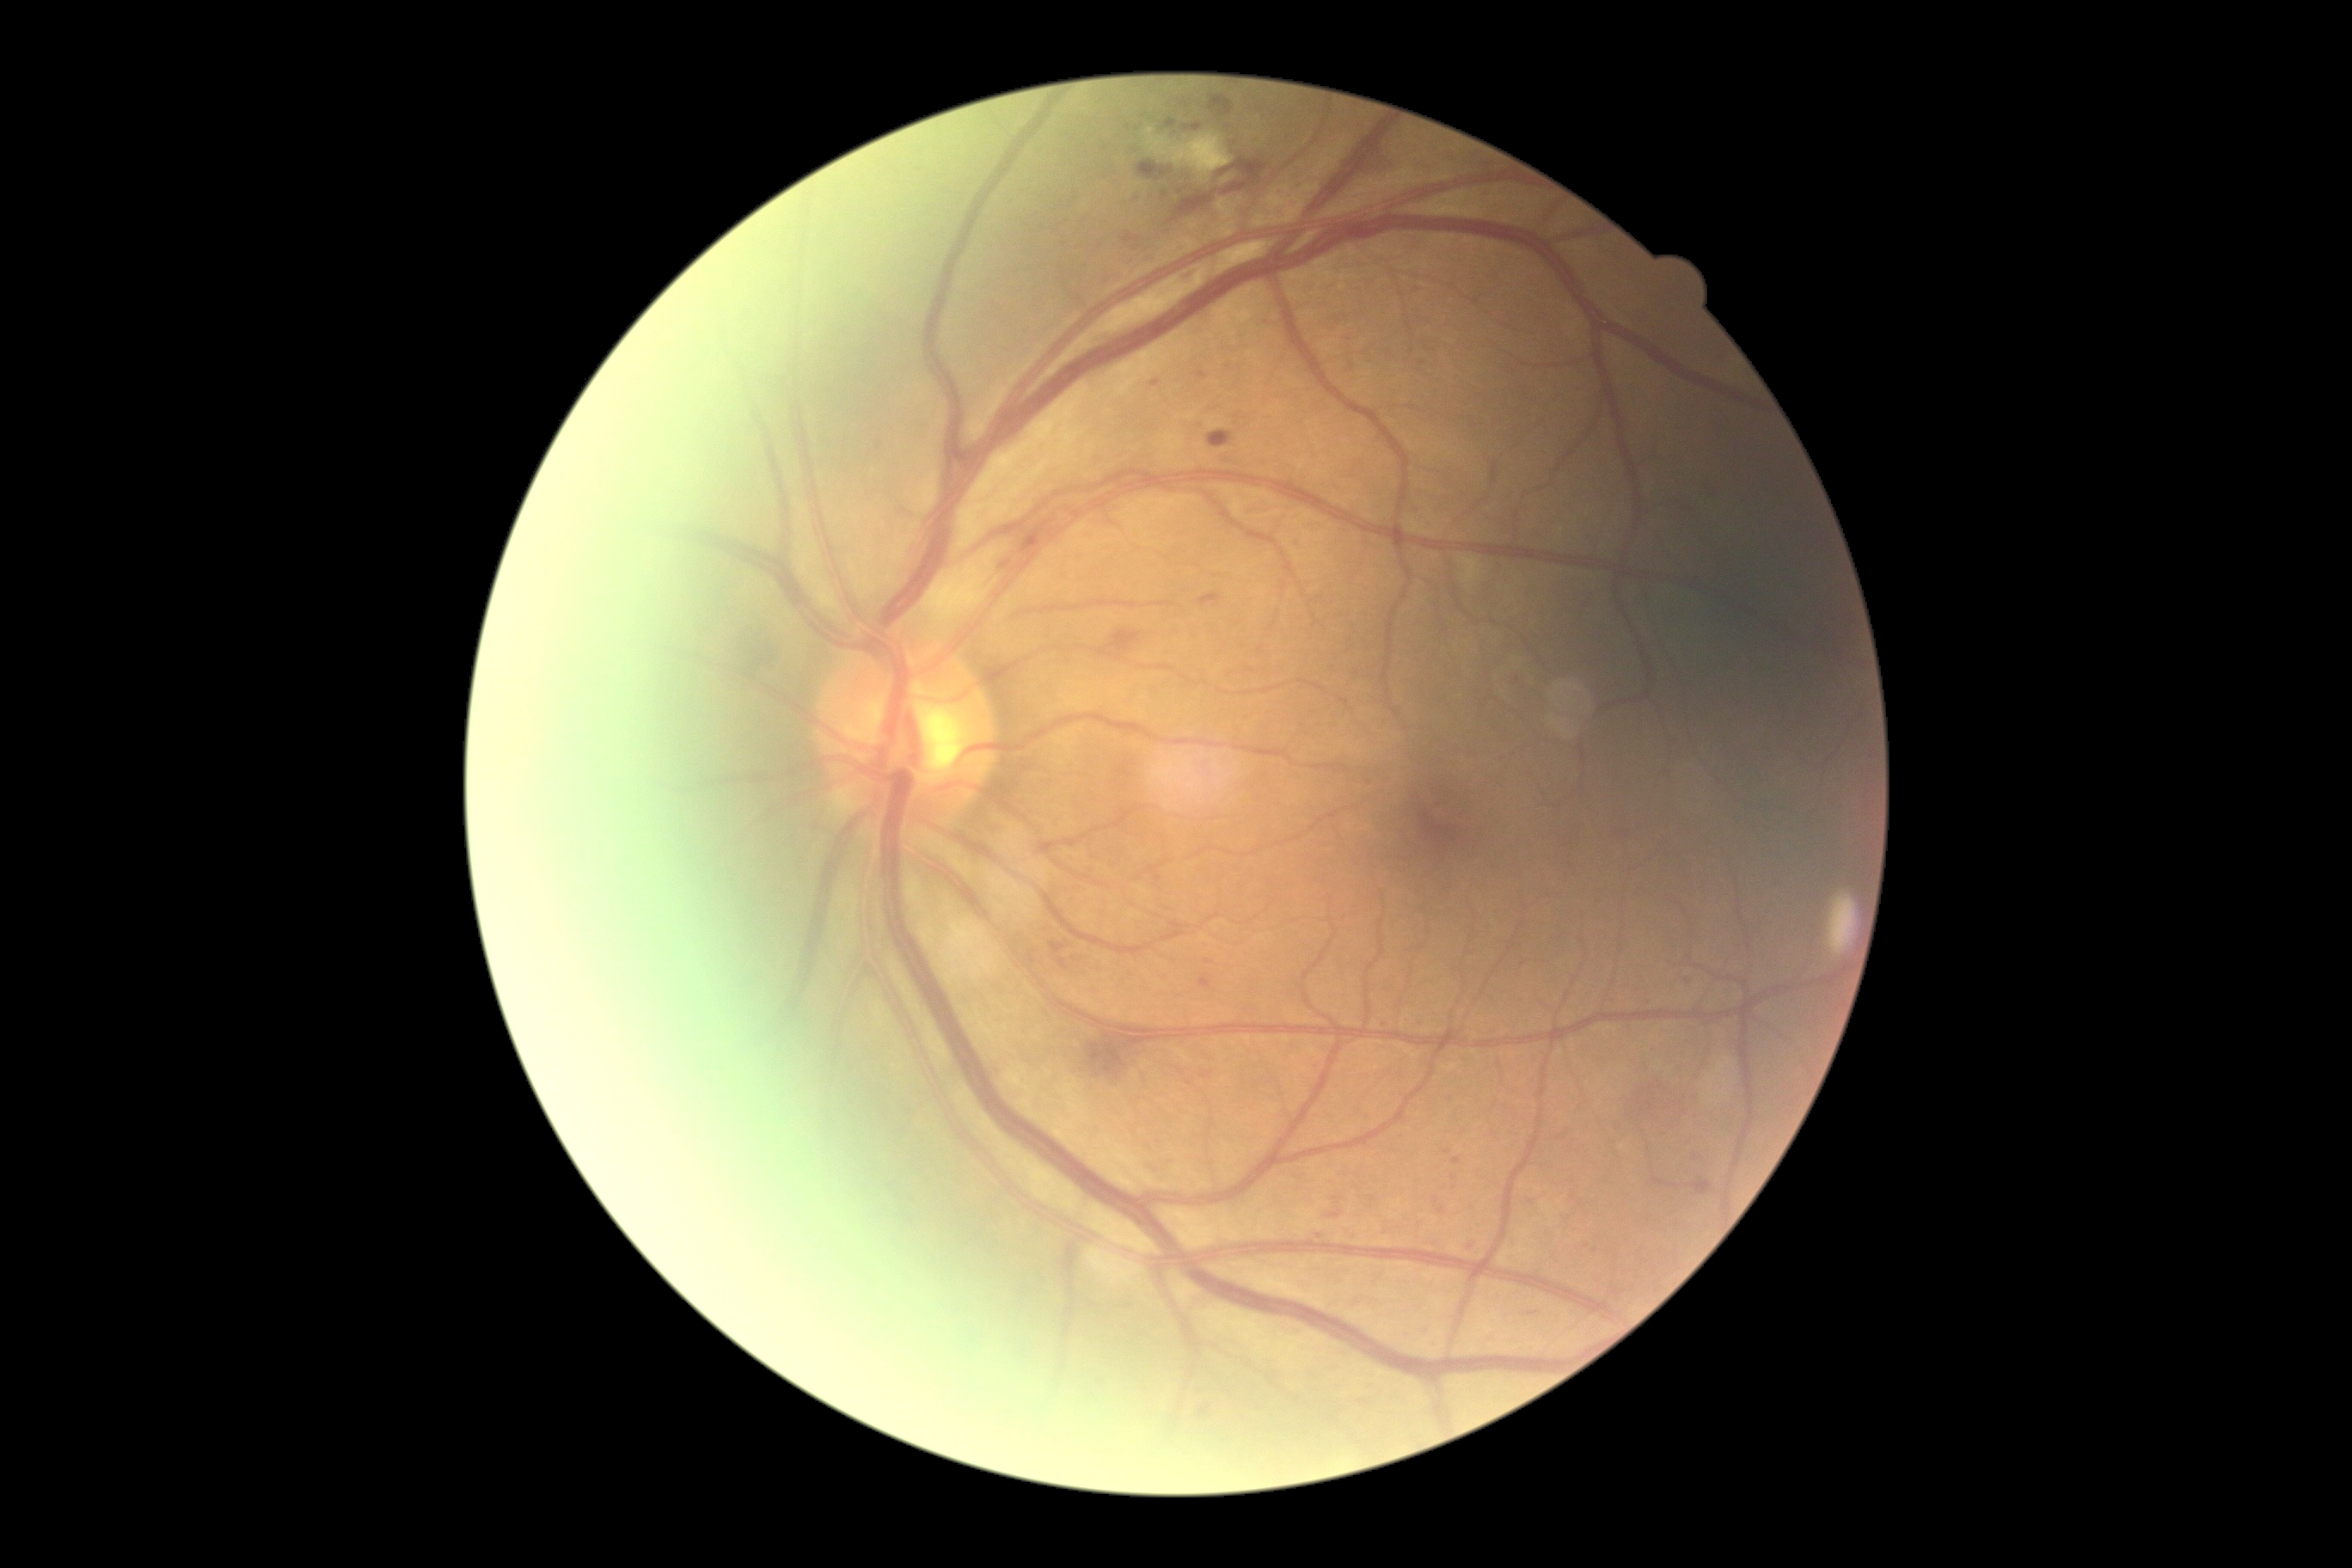

Diabetic retinopathy grade: moderate NPDR (2) — more than just microaneurysms but less than severe NPDR.